Color fundus photograph, dilated-pupil acquisition:
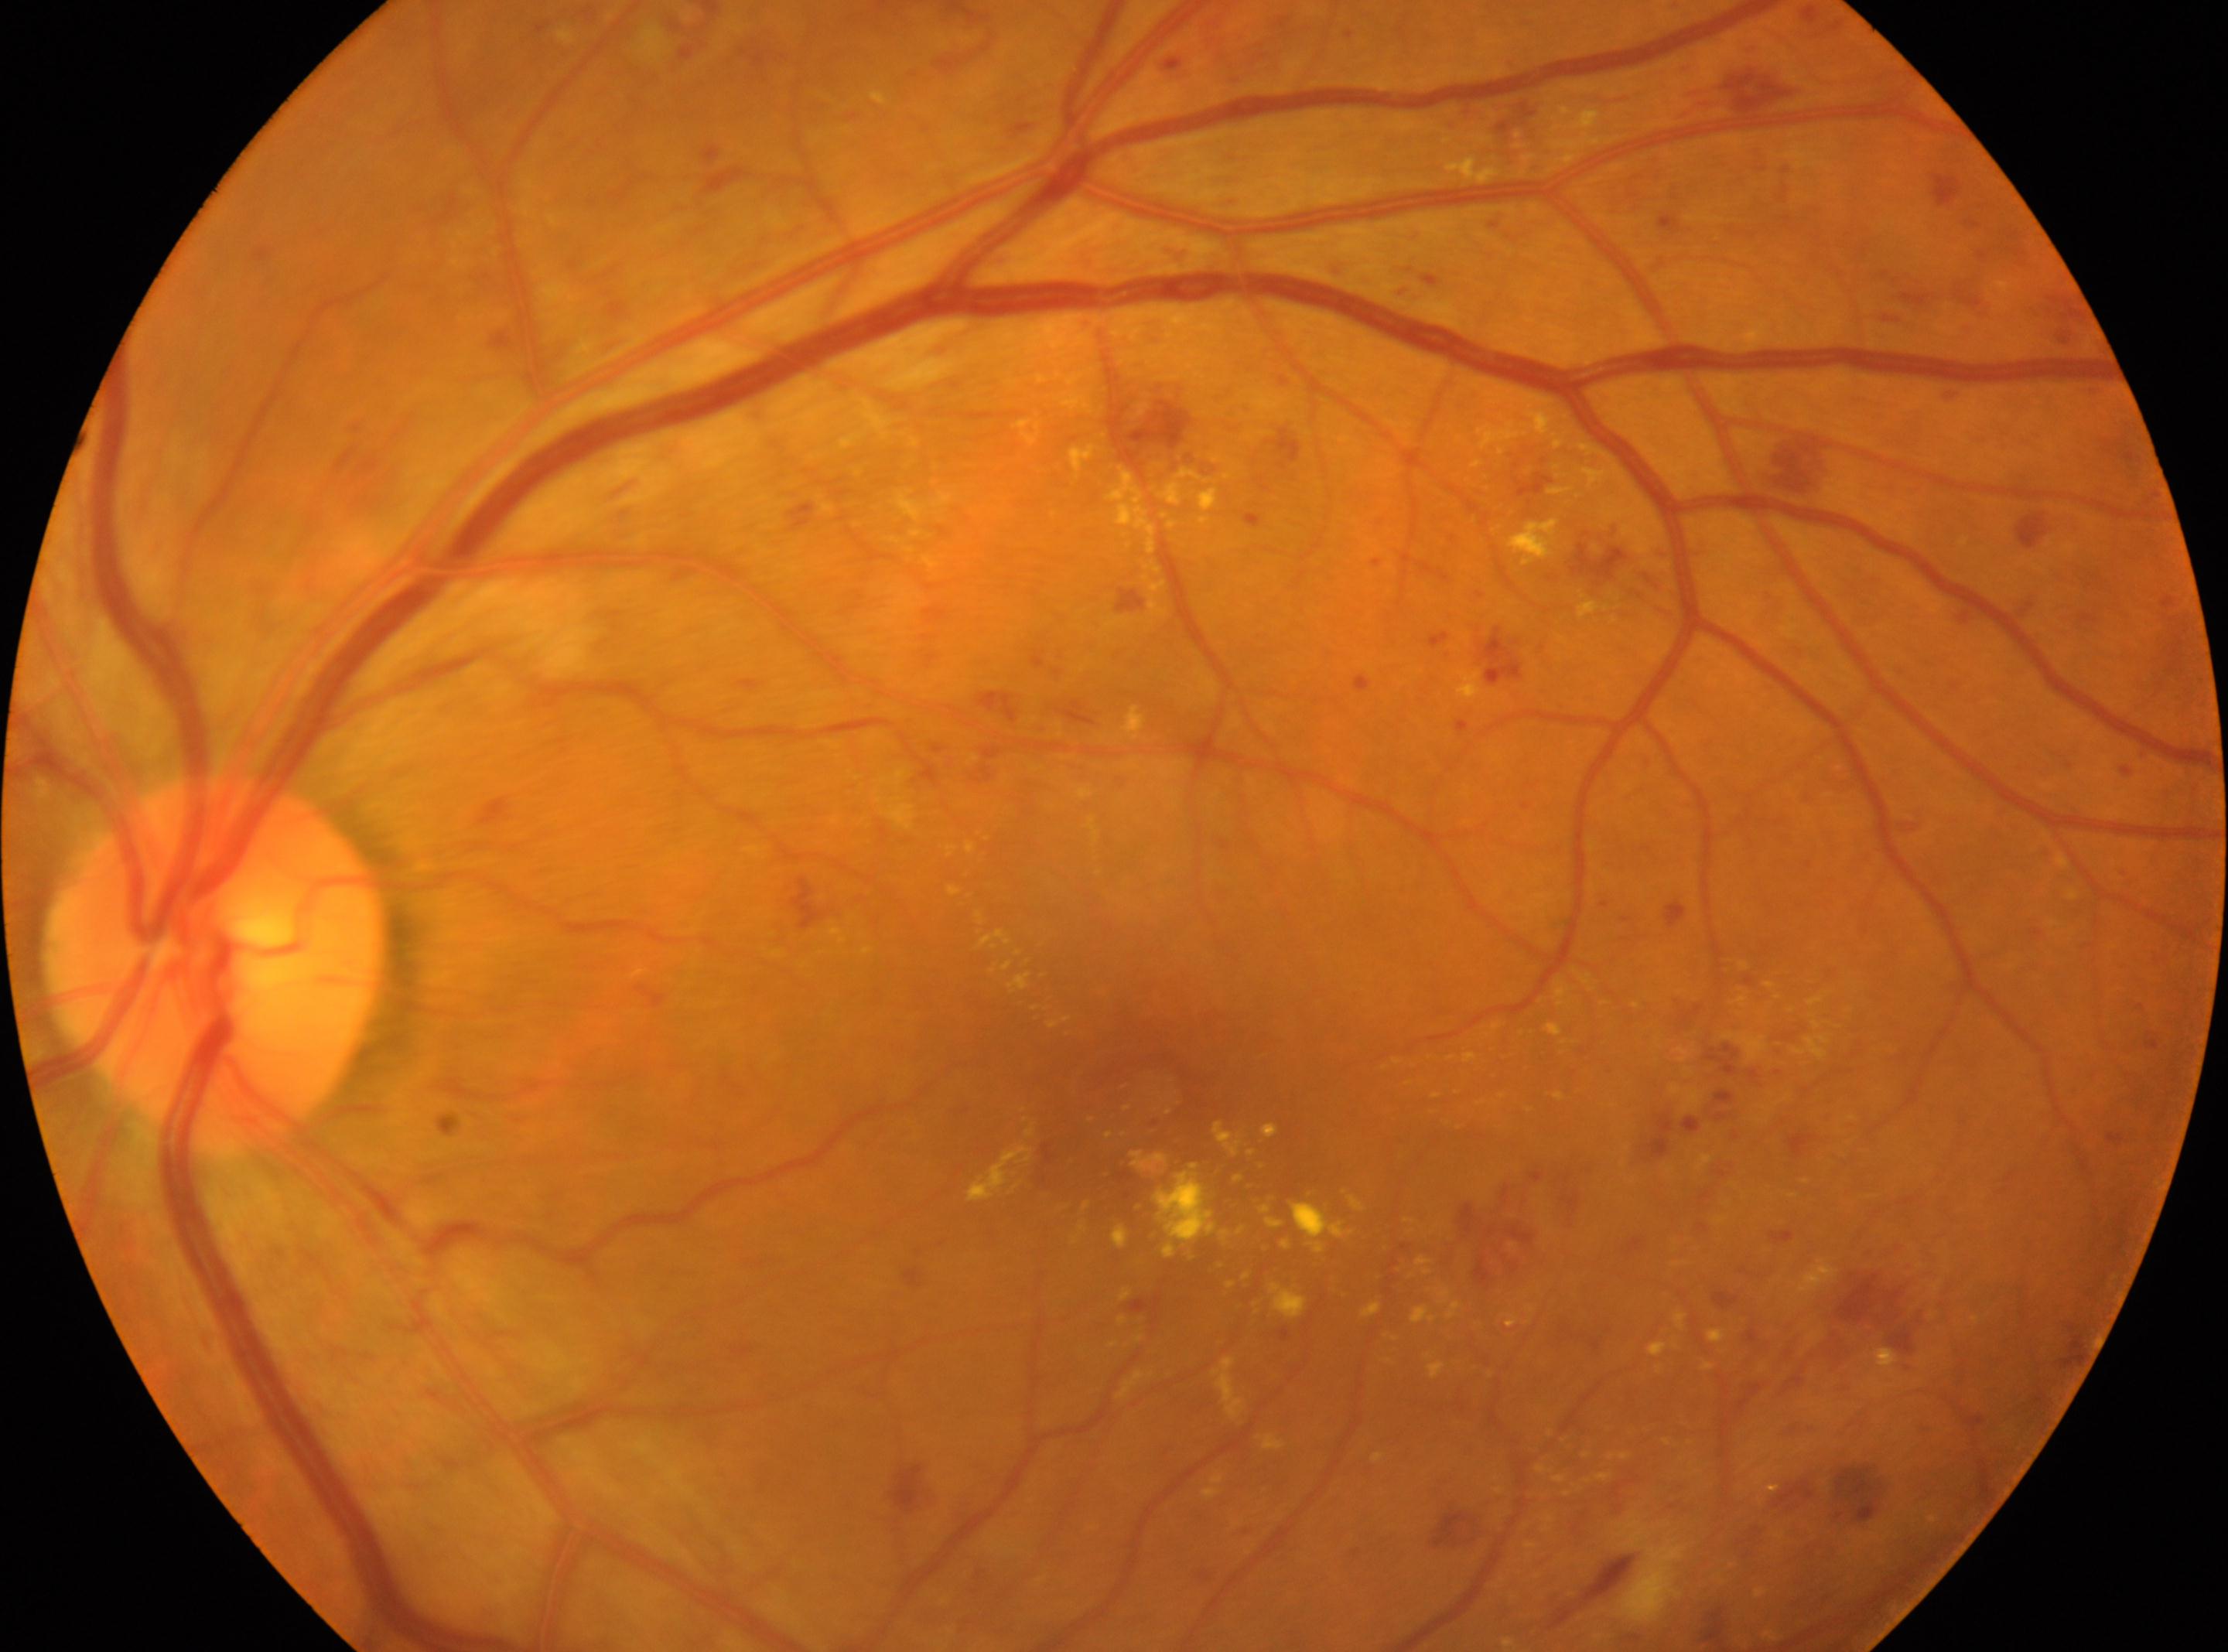

{"optic_disc": "(x=214, y=967)", "fovea": "(x=1133, y=1094)", "dr_grade": "3", "eye": "OS"}